FOV: 45 degrees.
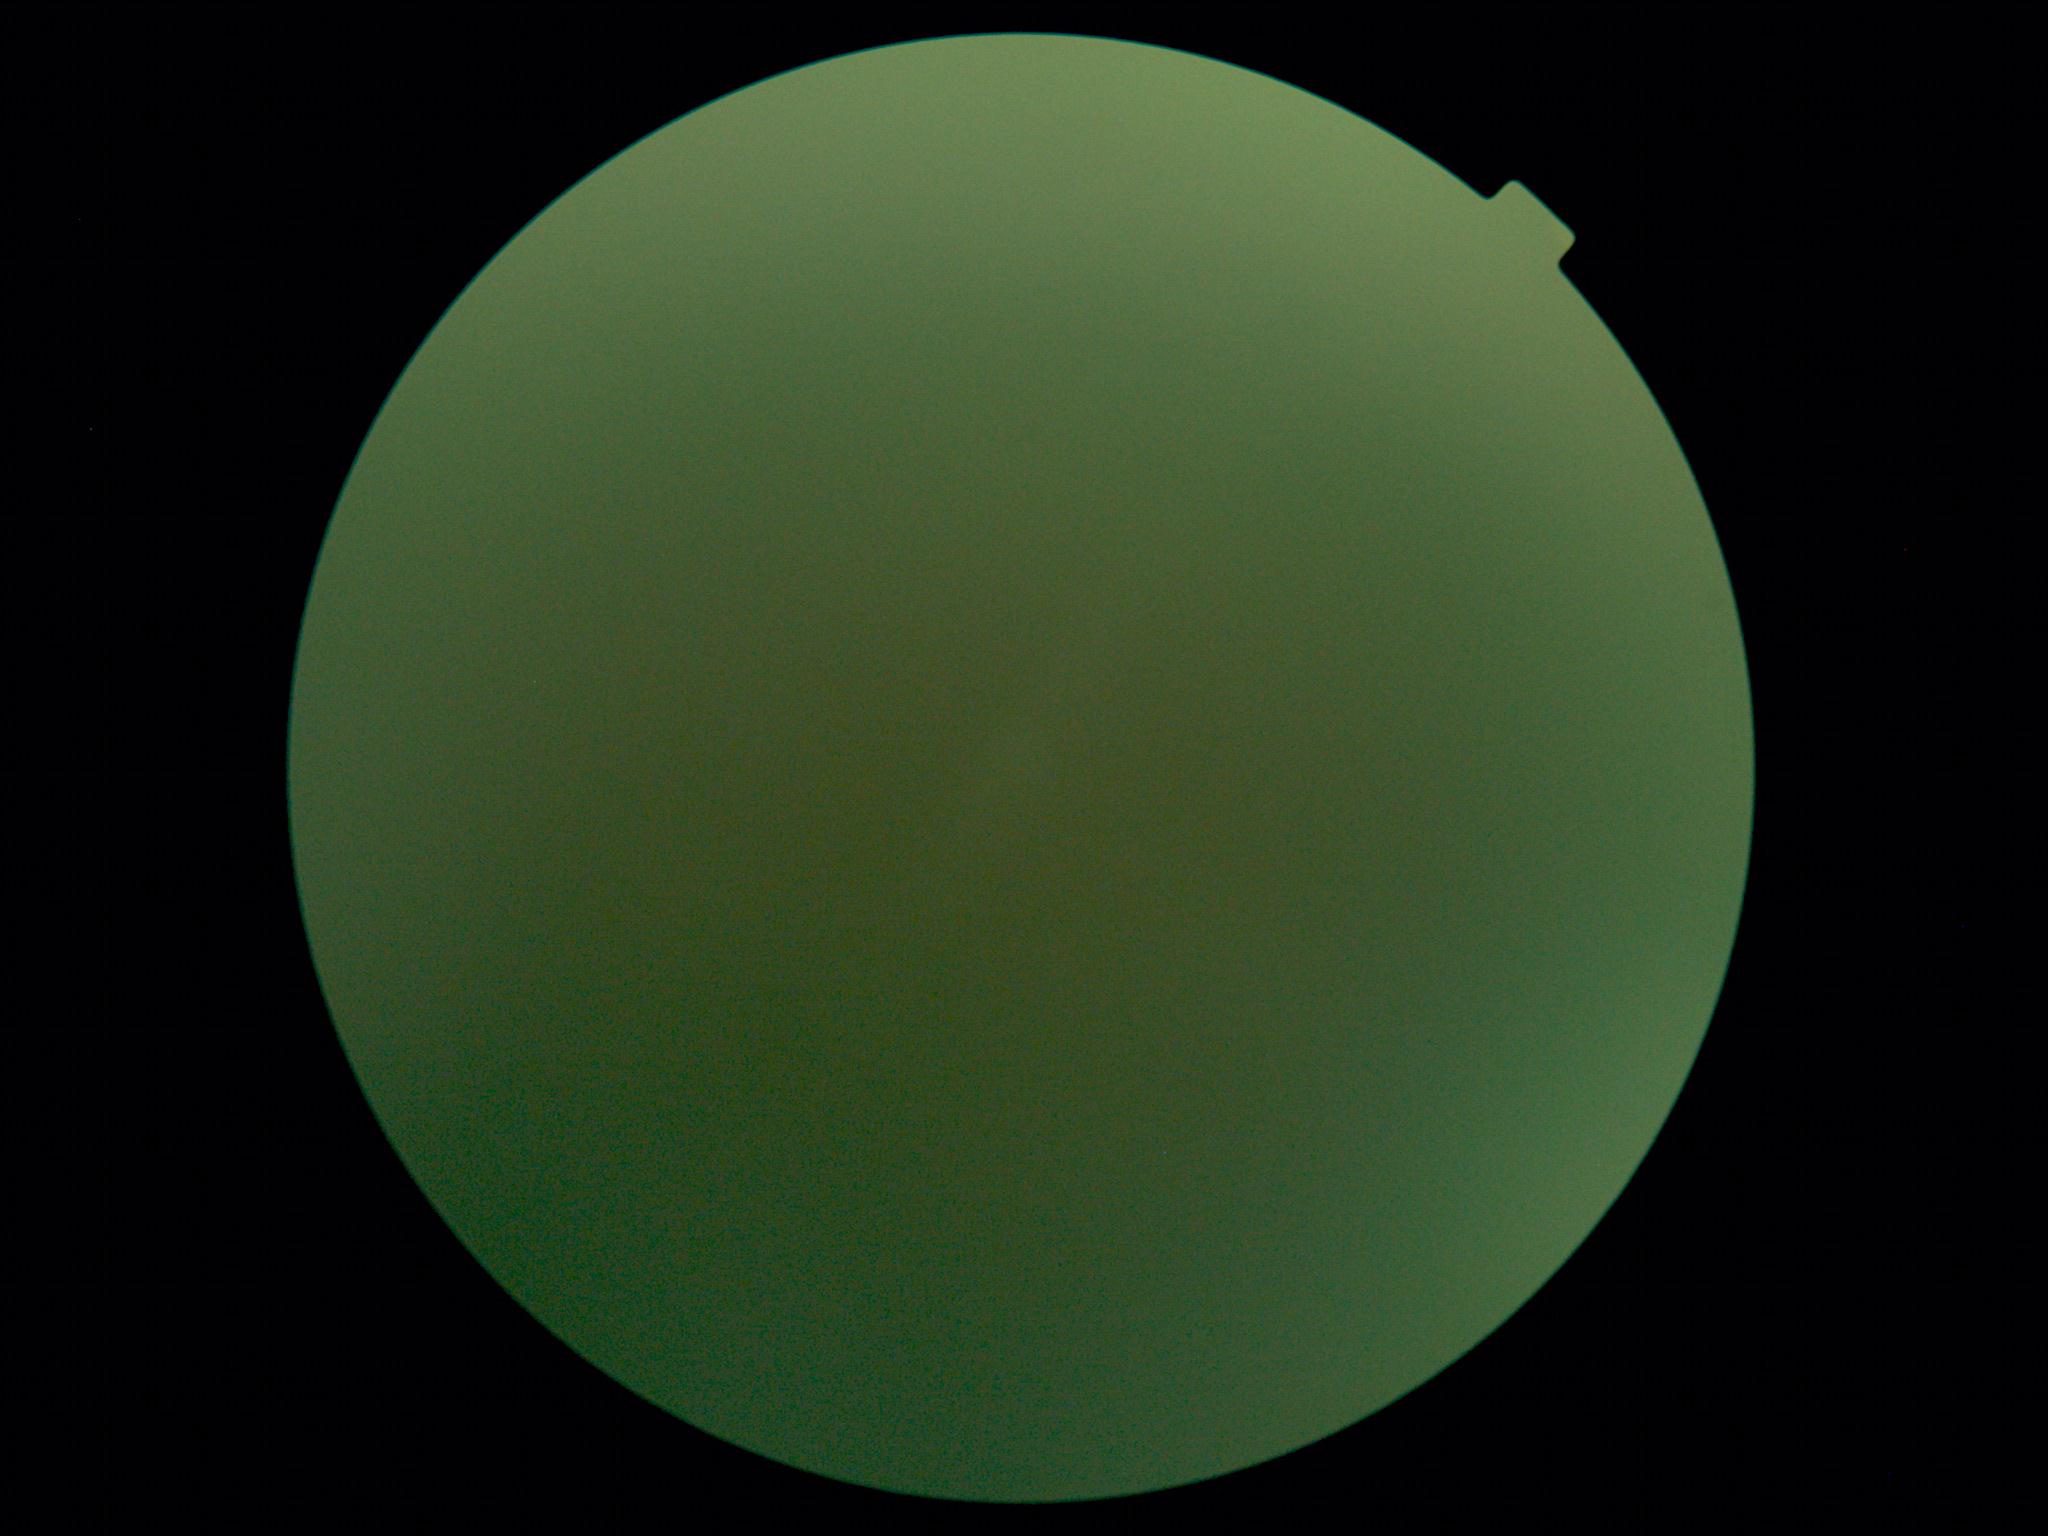 DR is ungradable due to poor image quality.